1932x1910
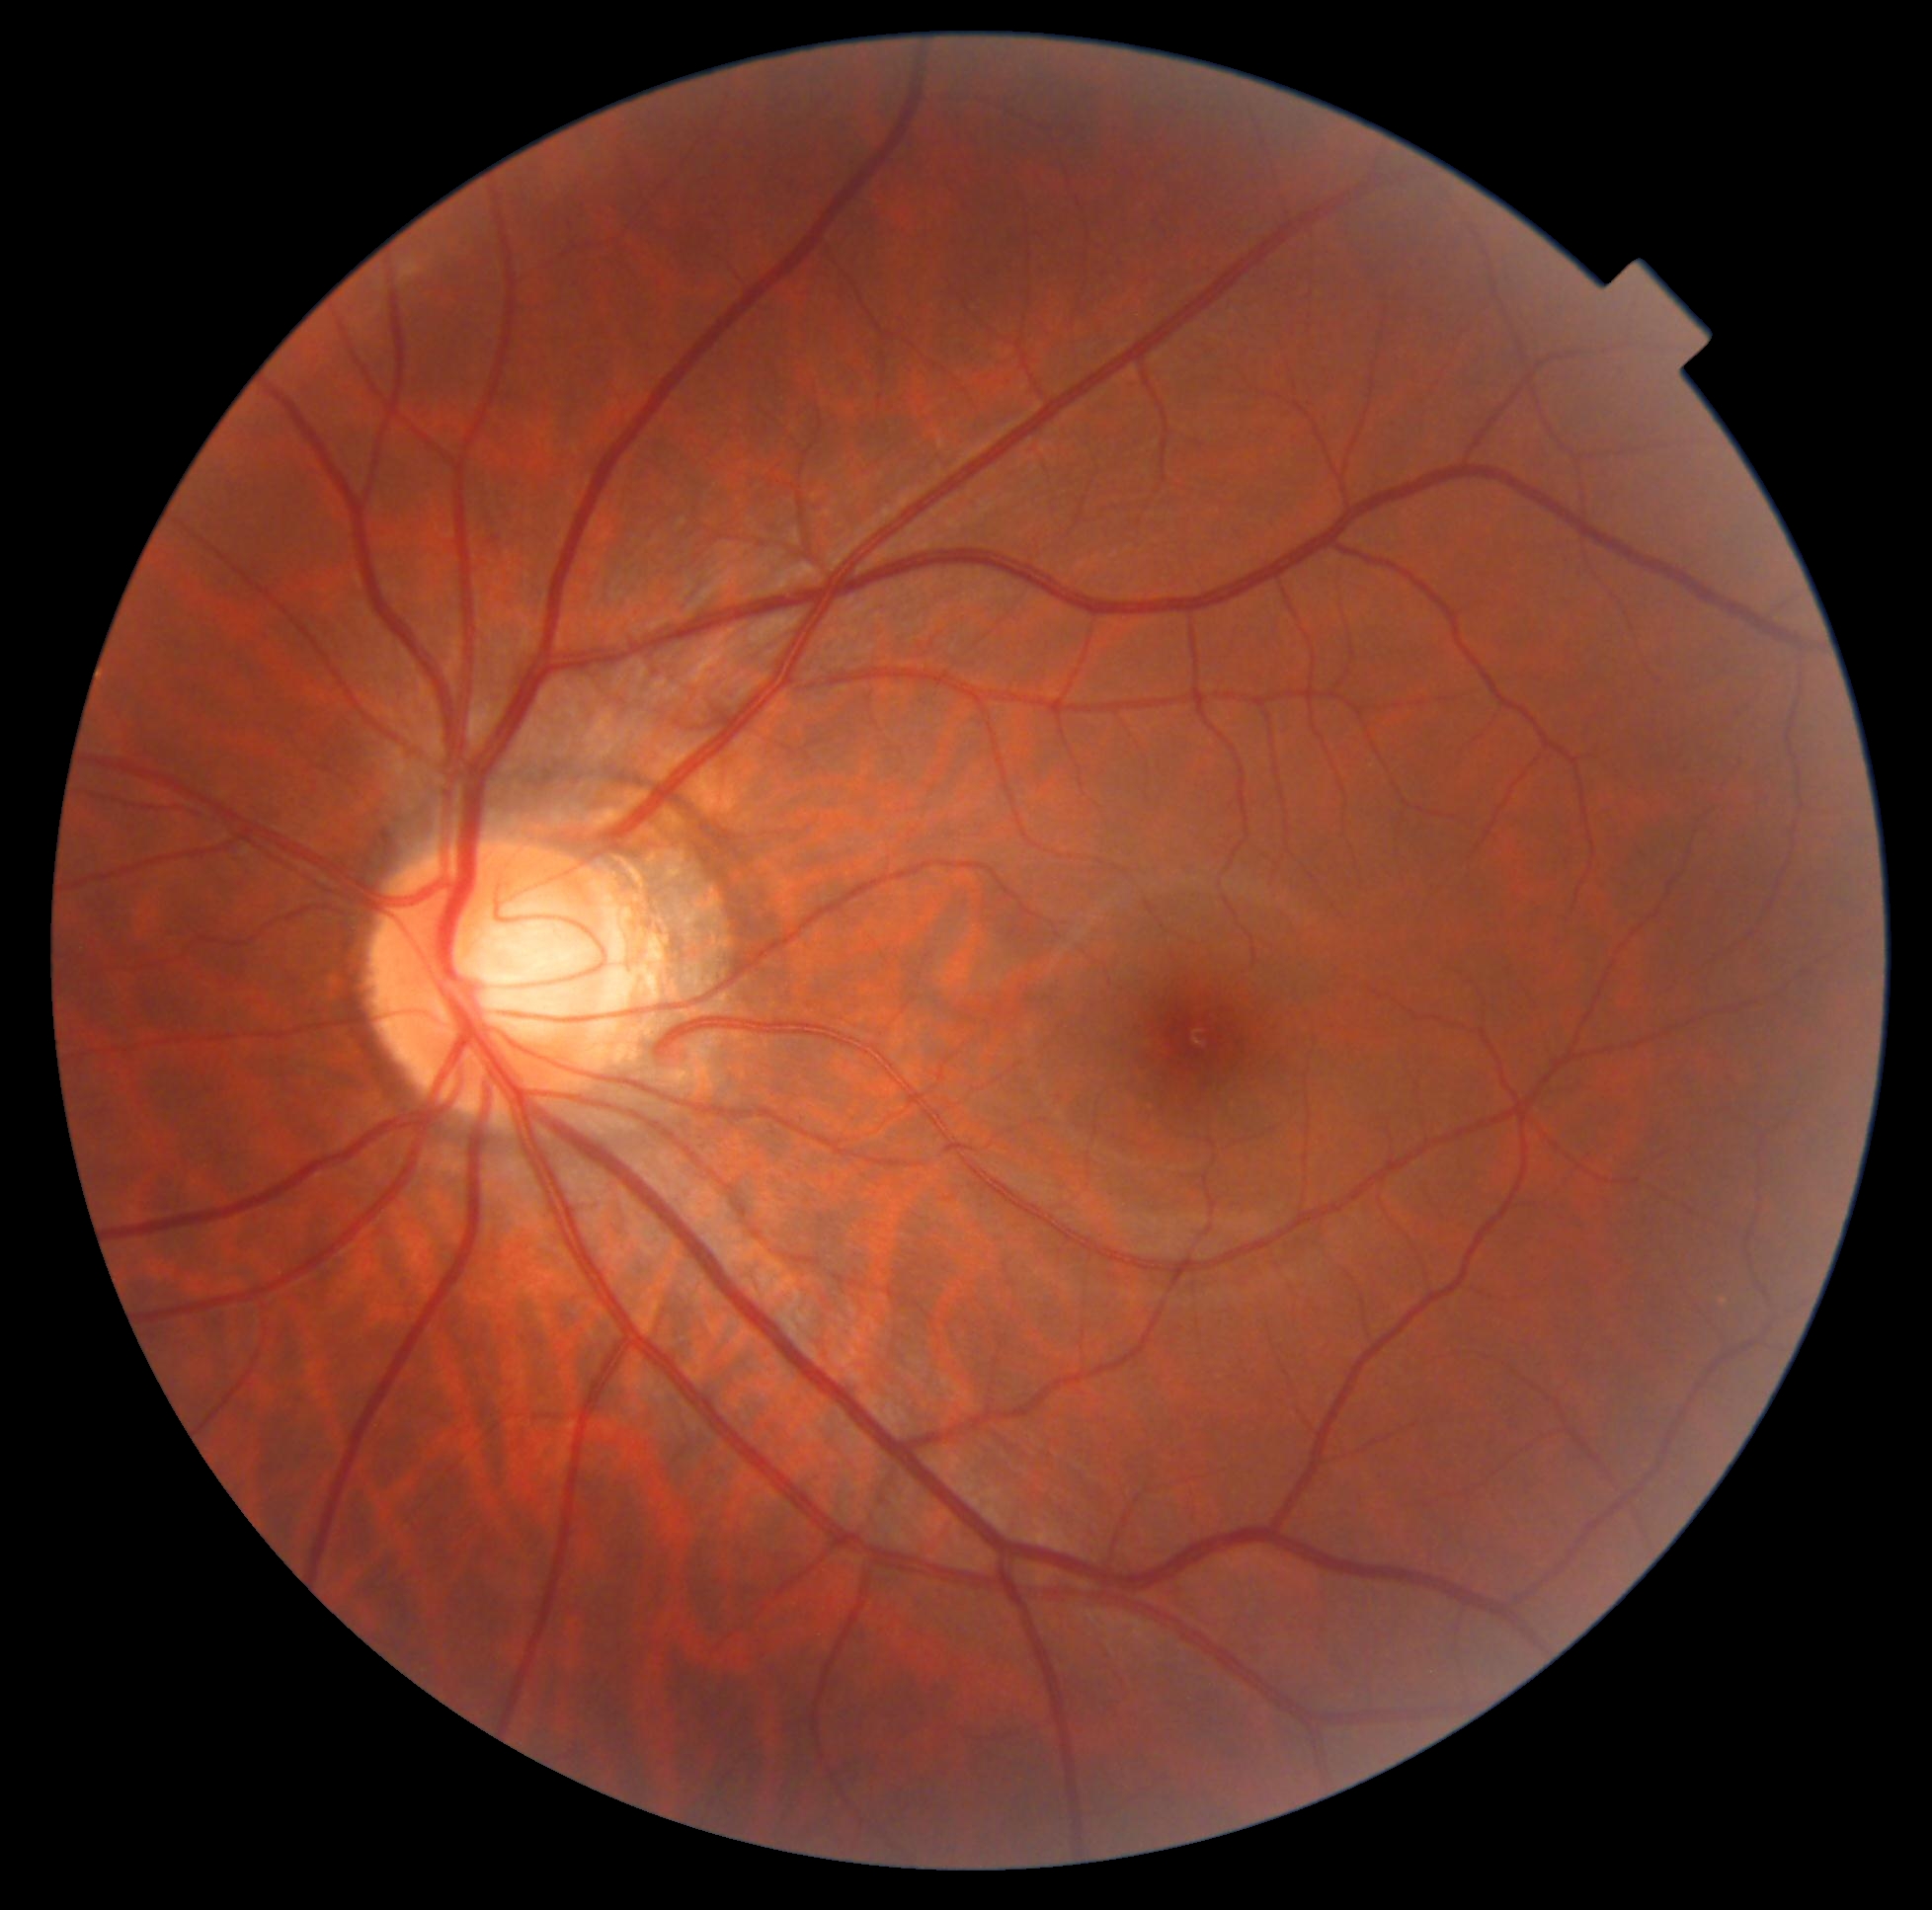

DR grade: 0.